Optic nerve head photograph
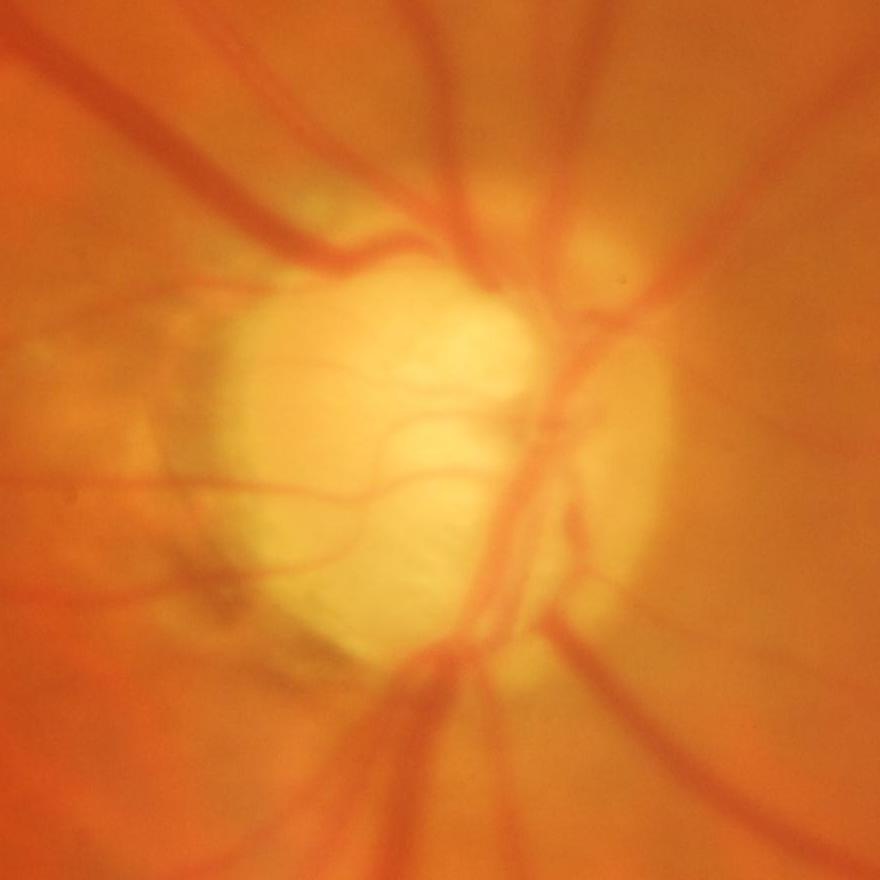

Glaucoma is present. The image shows evidence of glaucoma.